Camera: Remidio FOP fundus camera: 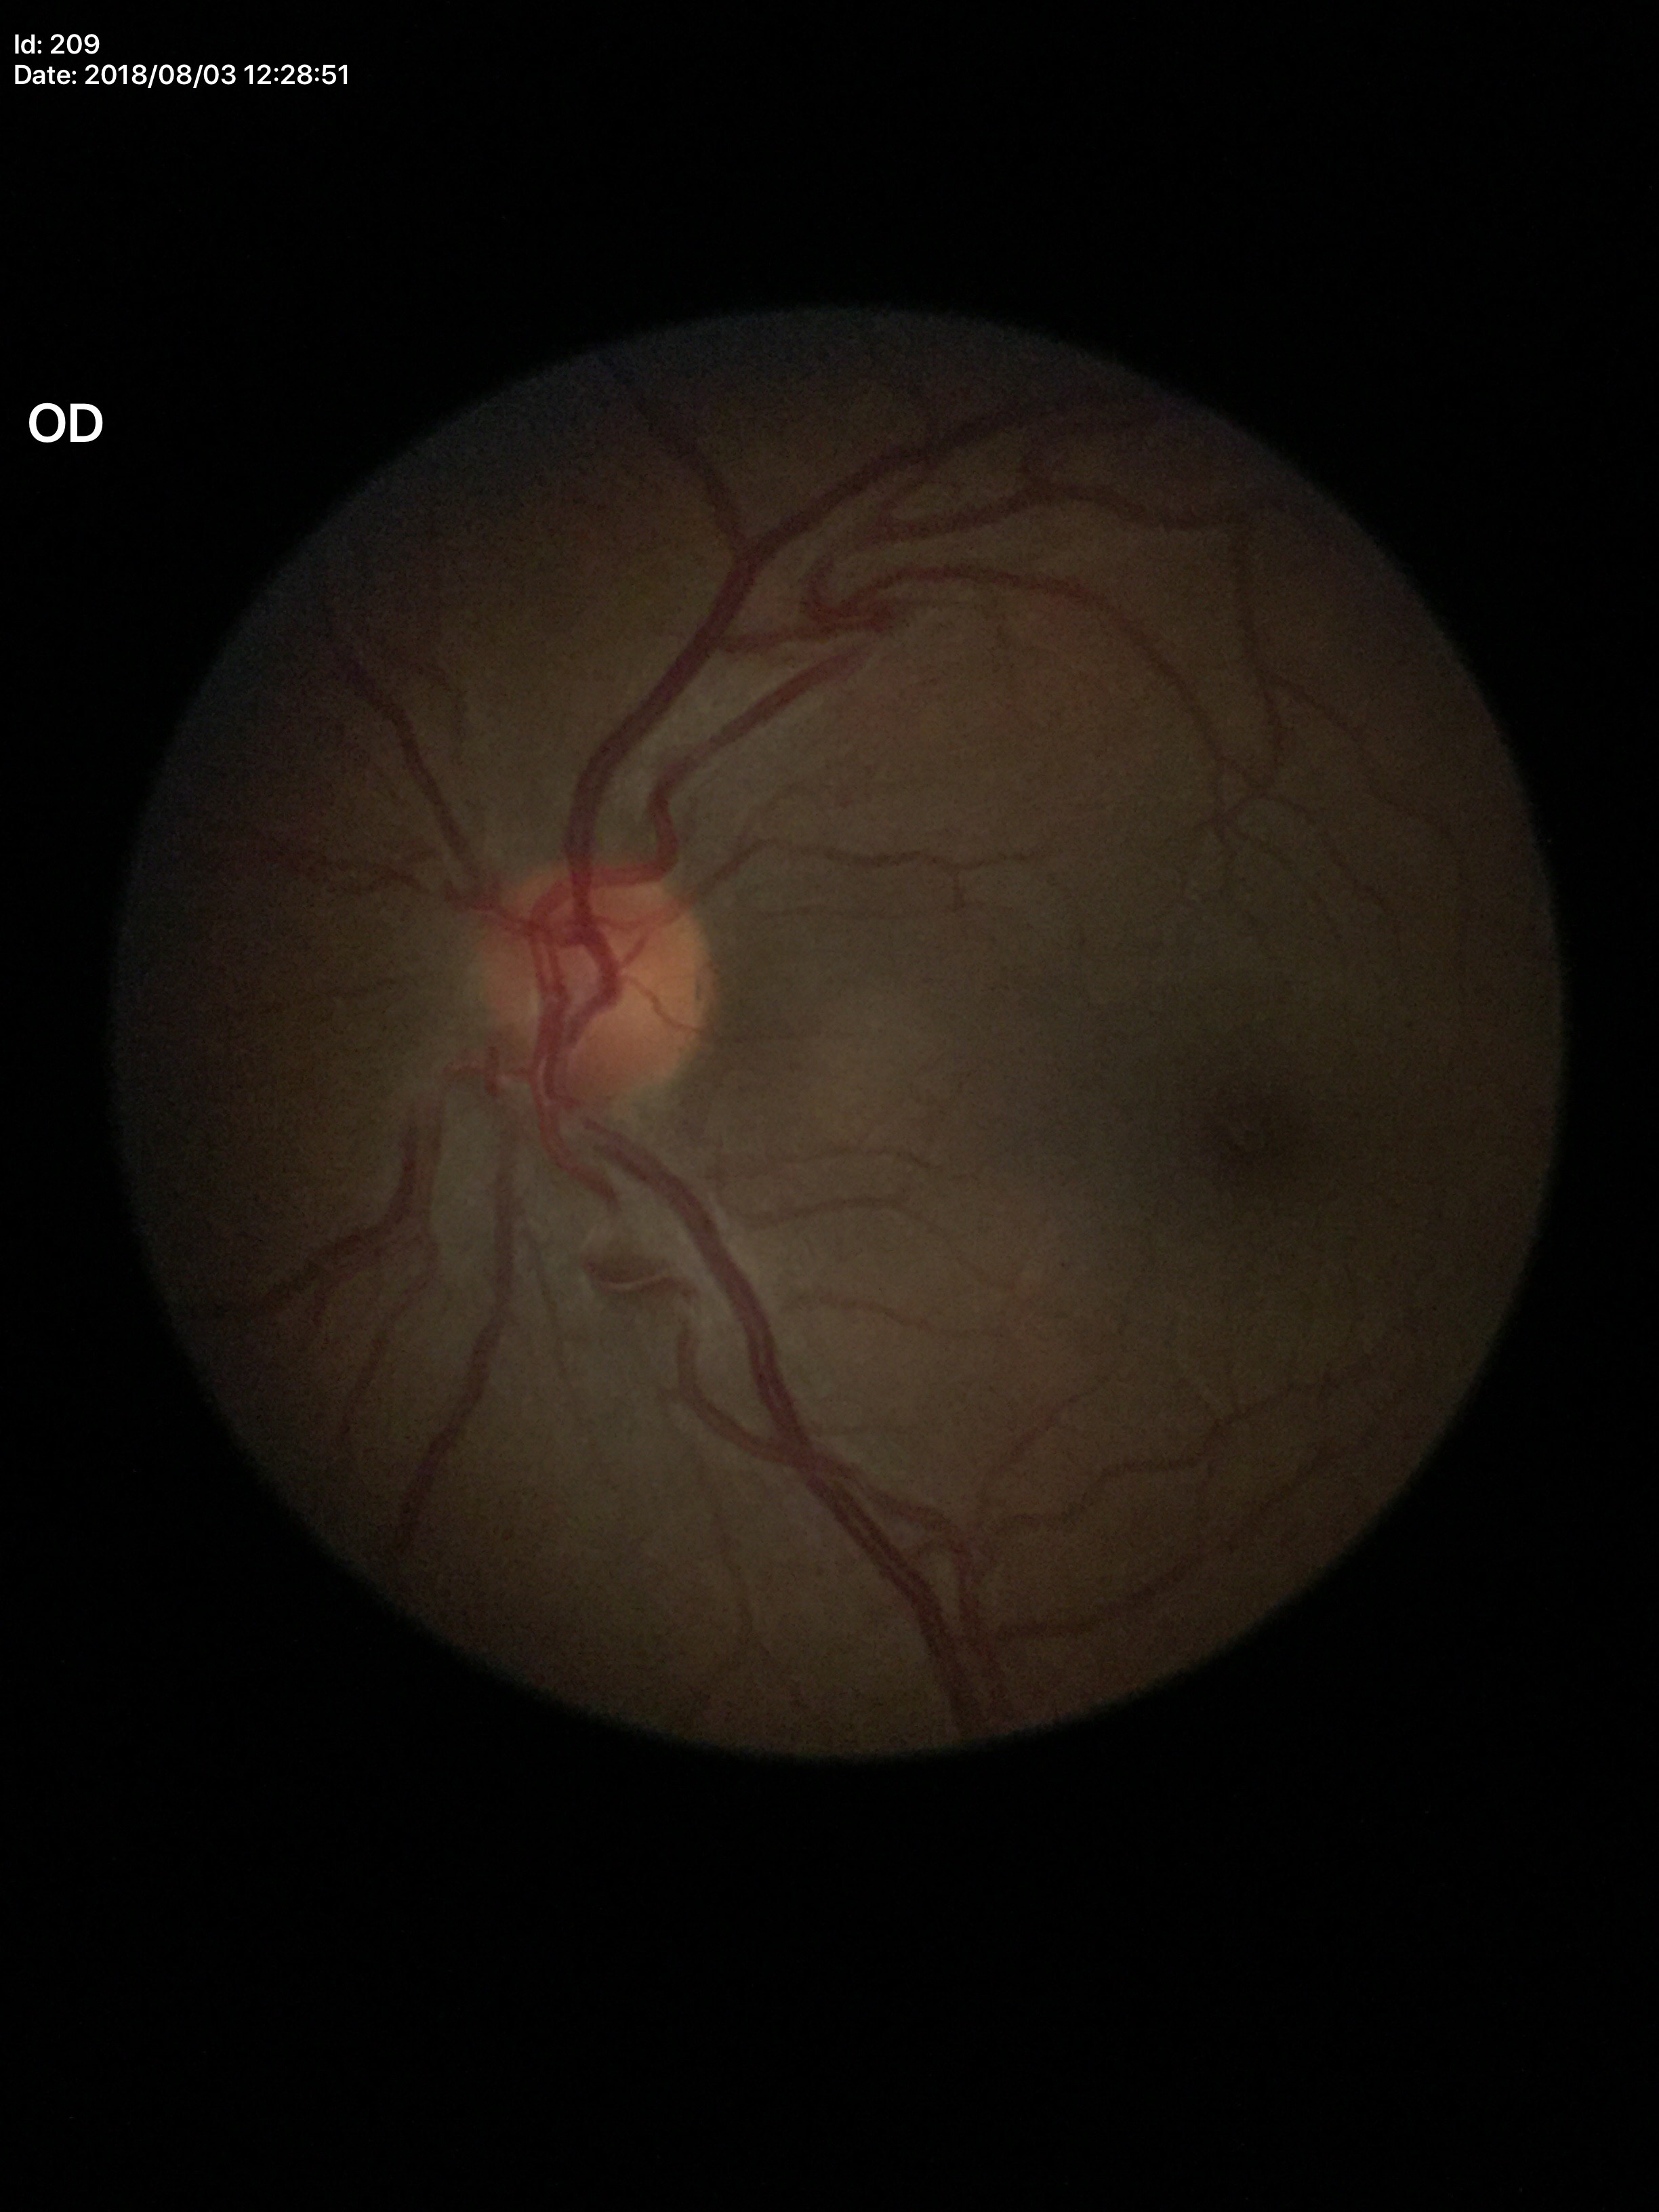
{
  "glaucoma_decision": "not suspect (all 5 graders called normal)",
  "vcdr": "0.41"
}